Portable fundus photograph:
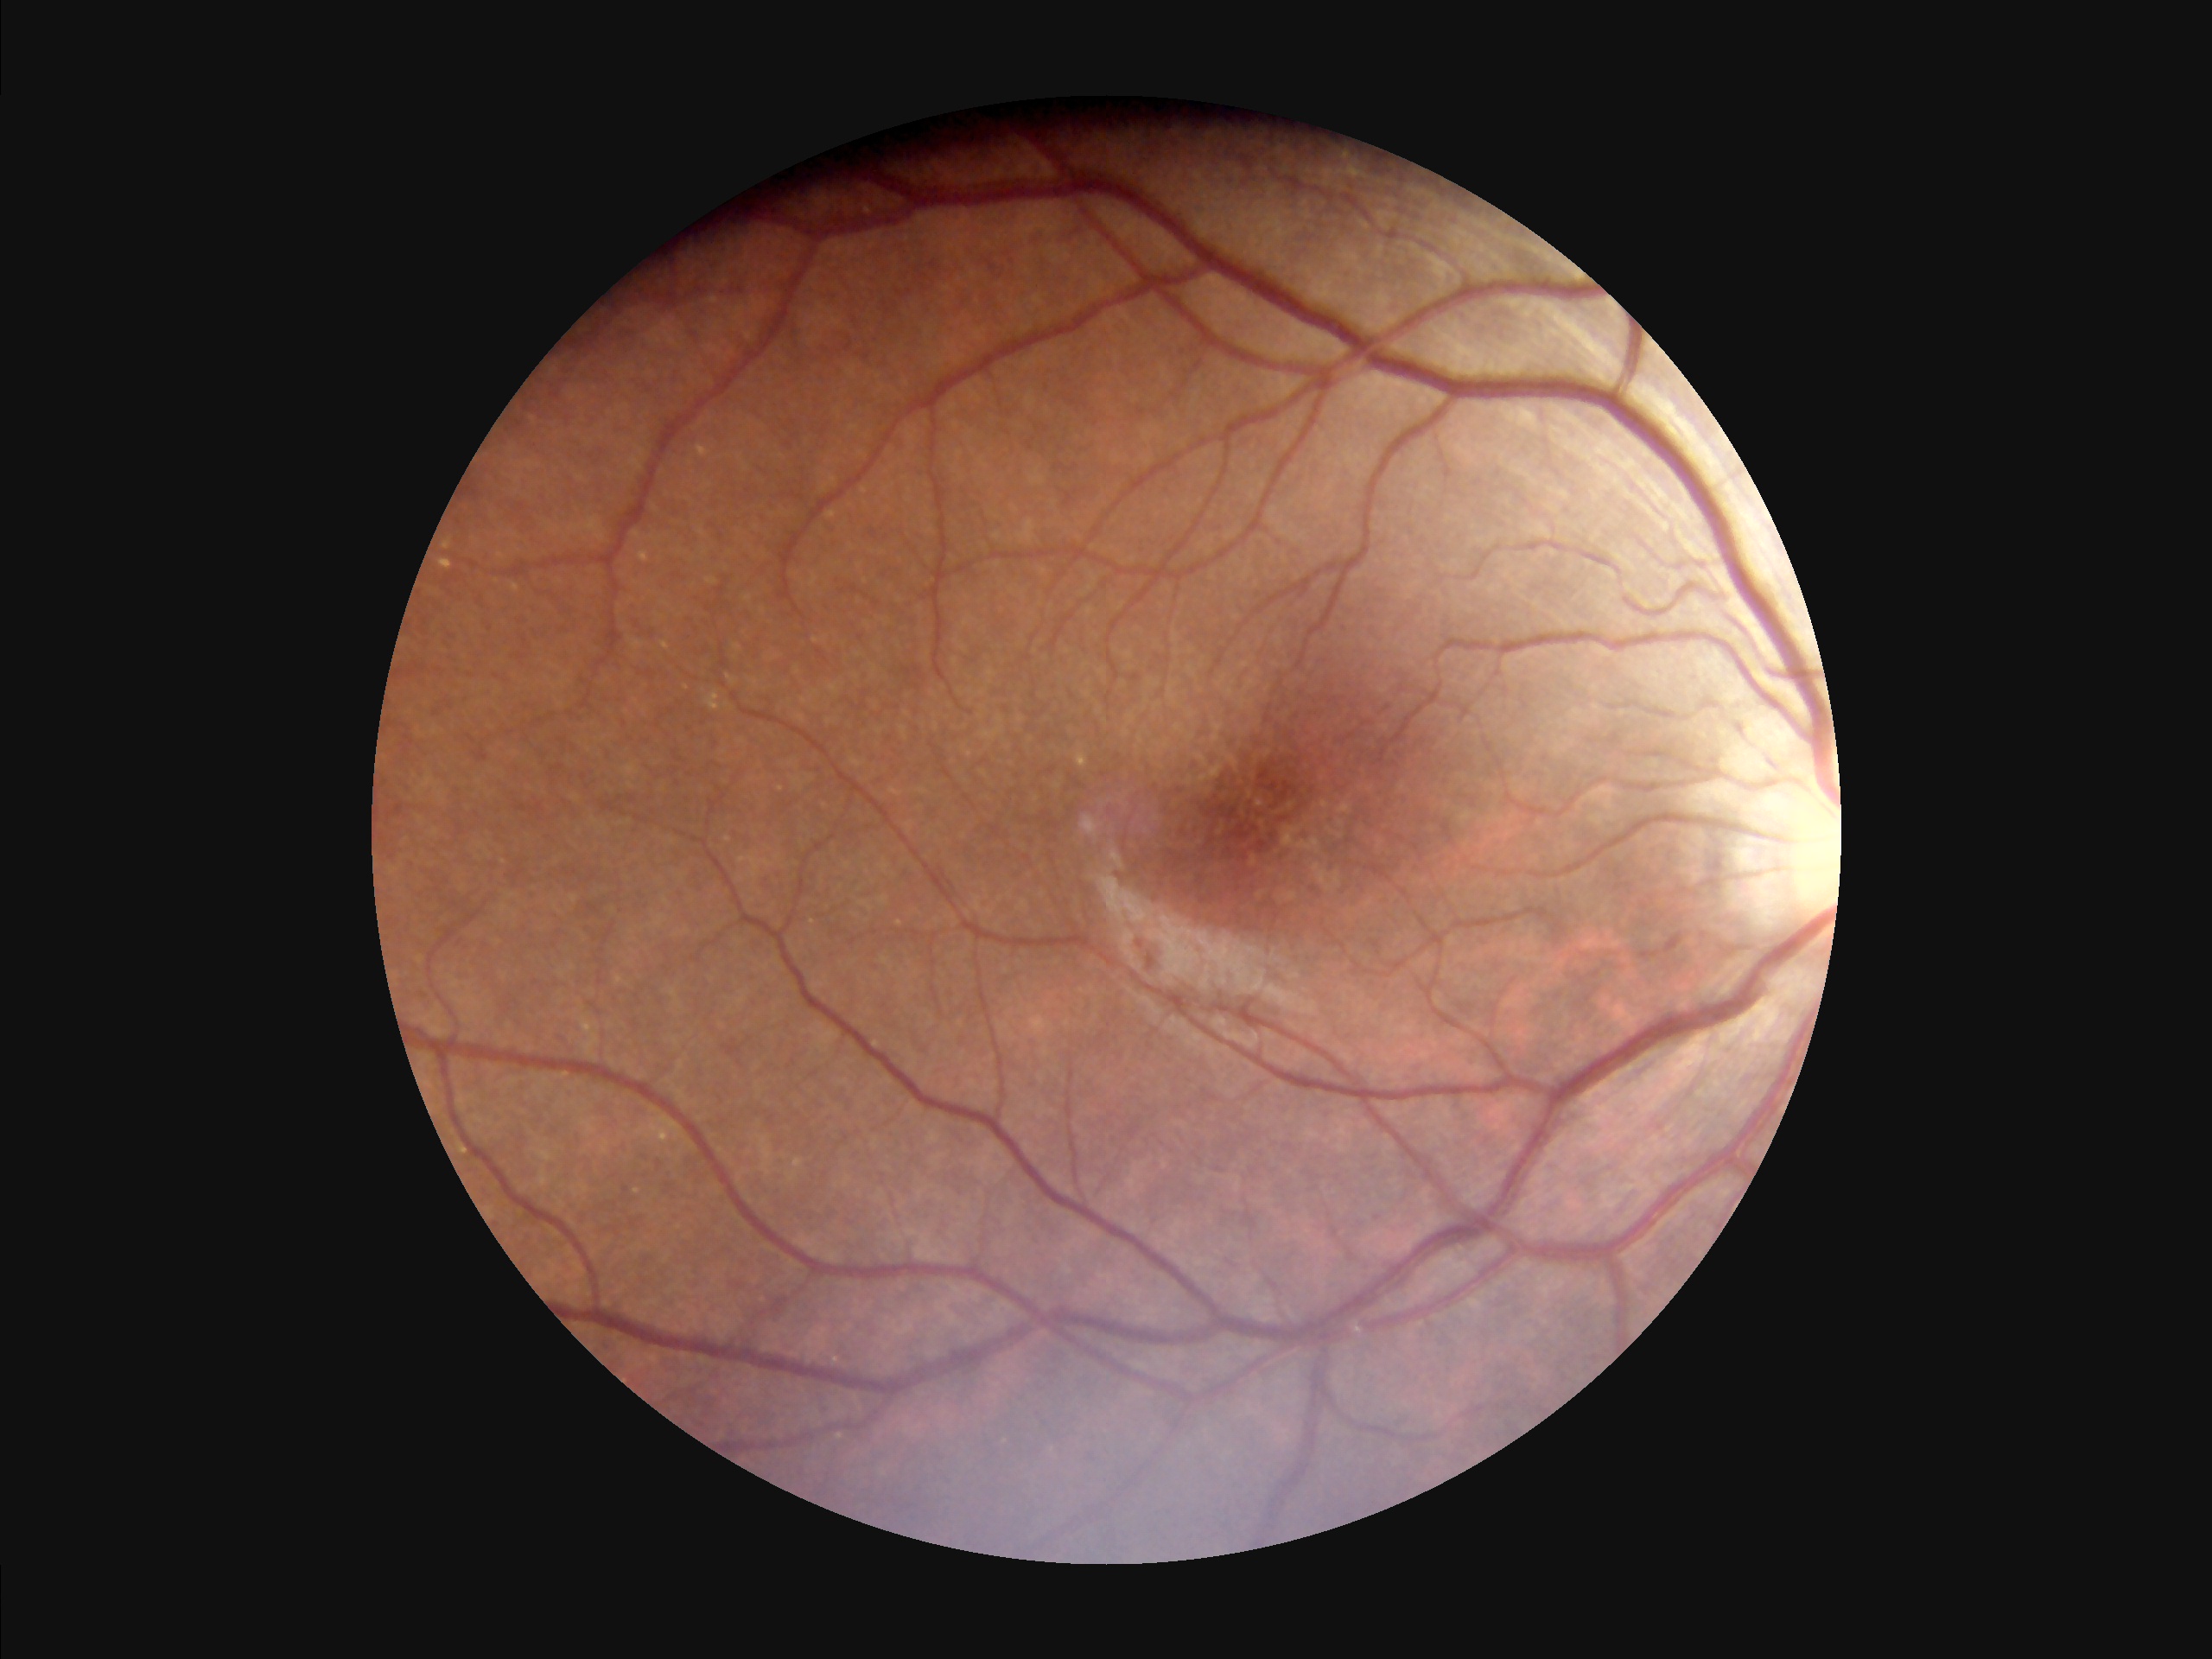

Illumination/color = even and well-balanced | Overall quality = good, gradable | Contrast = vessels and details readily distinguishable.